Camera: Nidek AFC-330 — 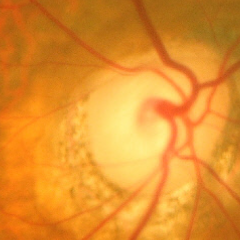 Impression = advanced-stage glaucoma.